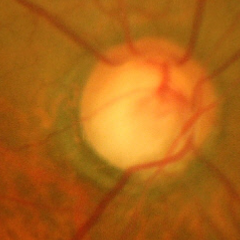 Q: What is the glaucoma diagnosis?
A: Advanced-stage glaucoma.